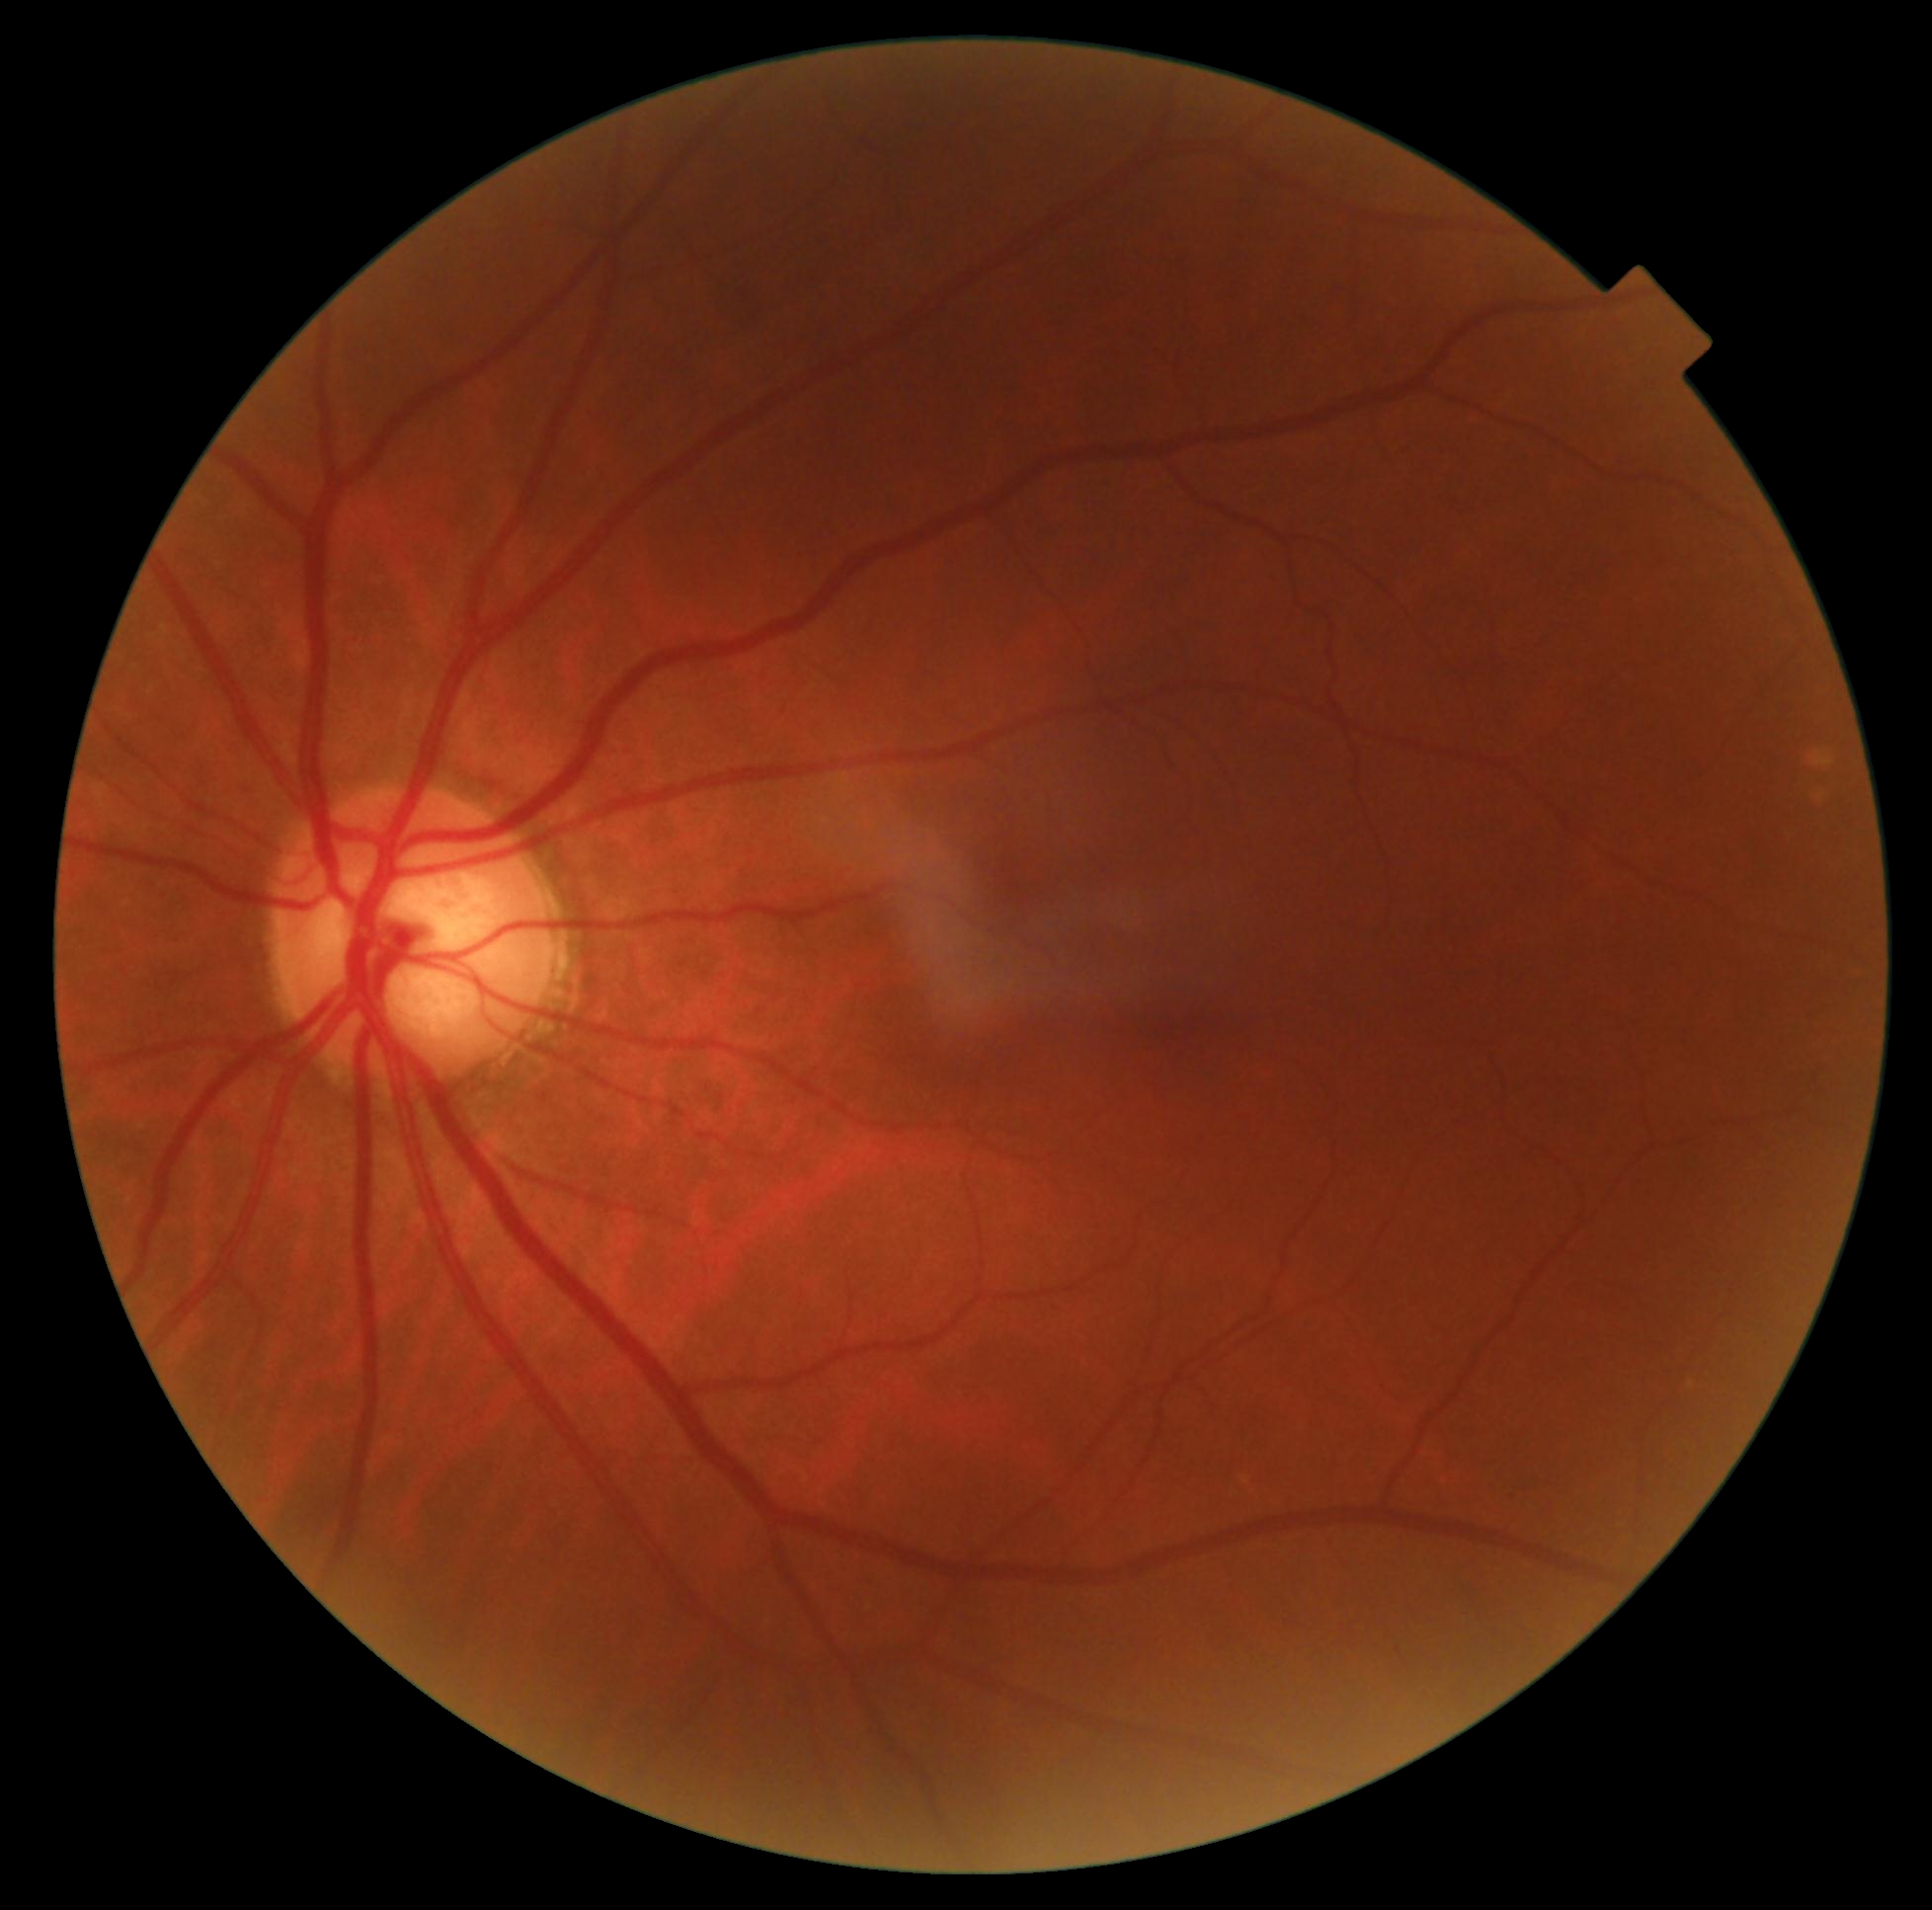
diabetic retinopathy (DR): grade 0 (no apparent retinopathy).